Captured on a Remidio FOP fundus camera. Fundus photo.
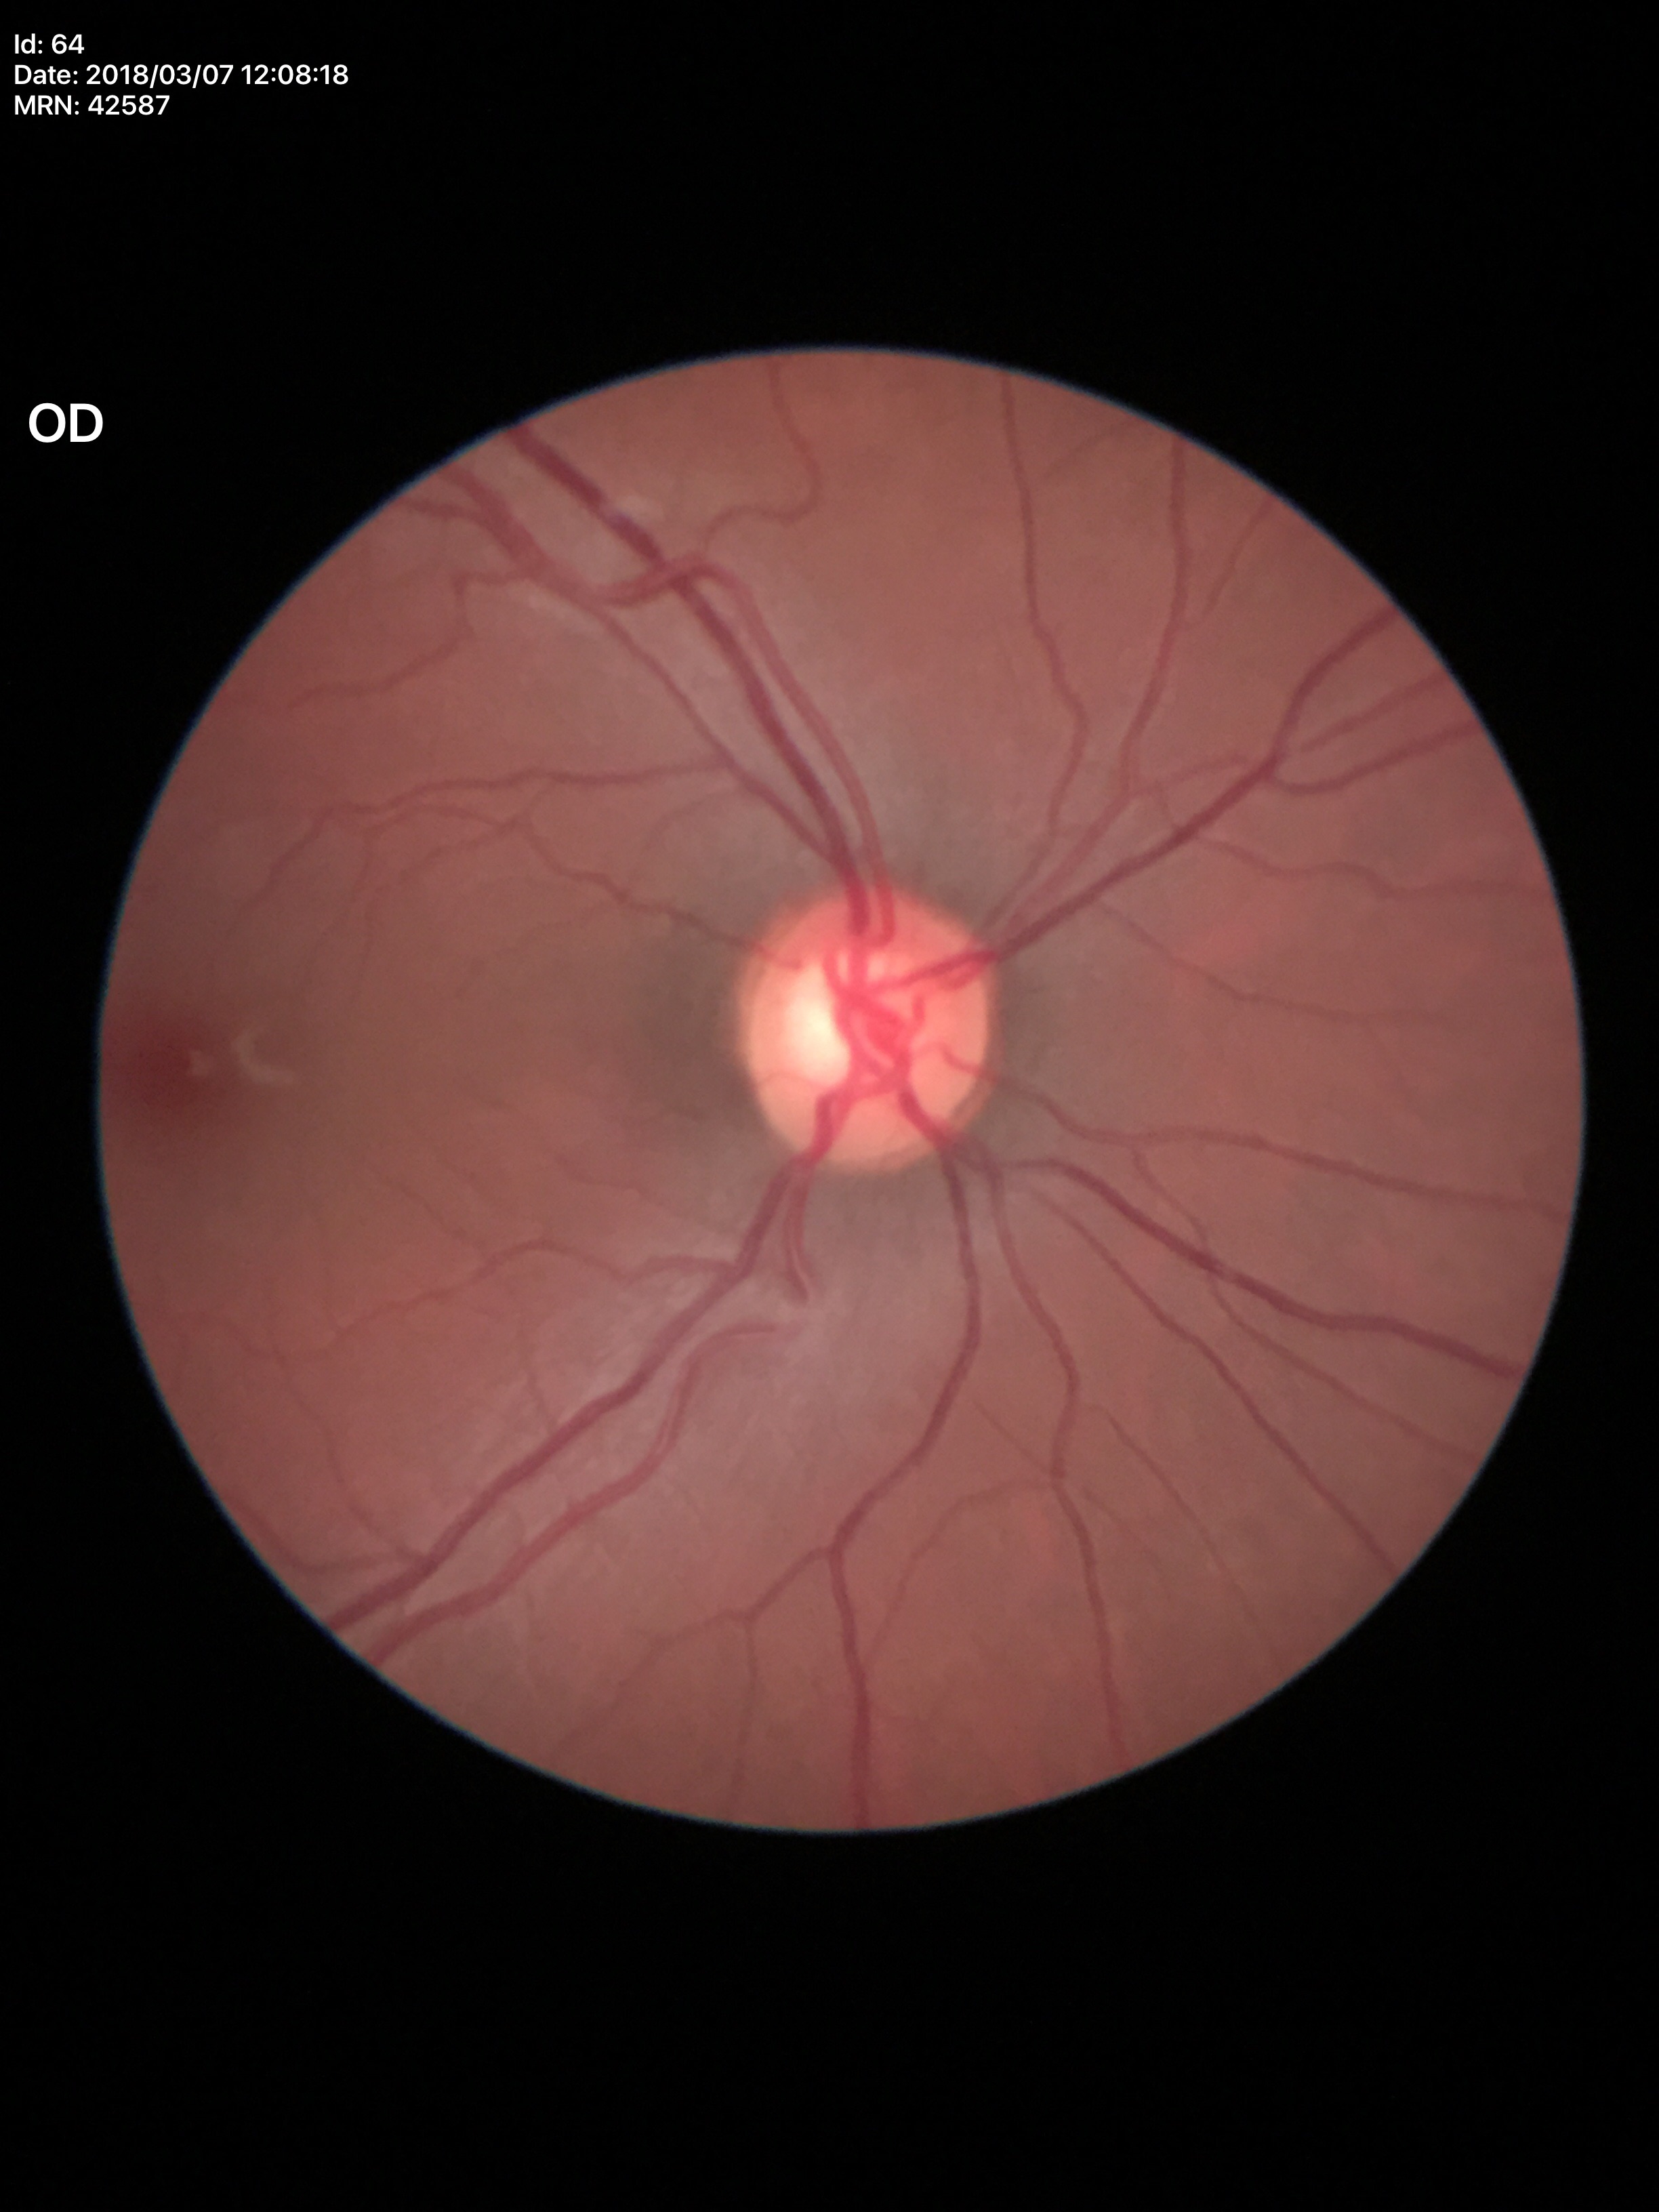
  glaucoma_decision: not suspect
  vcdr: 0.59